Captured on a Topcon TRC-50DX fundus camera, CFP, posterior pole view, 2228 x 1652 pixels, mydriatic (tropicamide and phenylephrine), FOV: 50 degrees
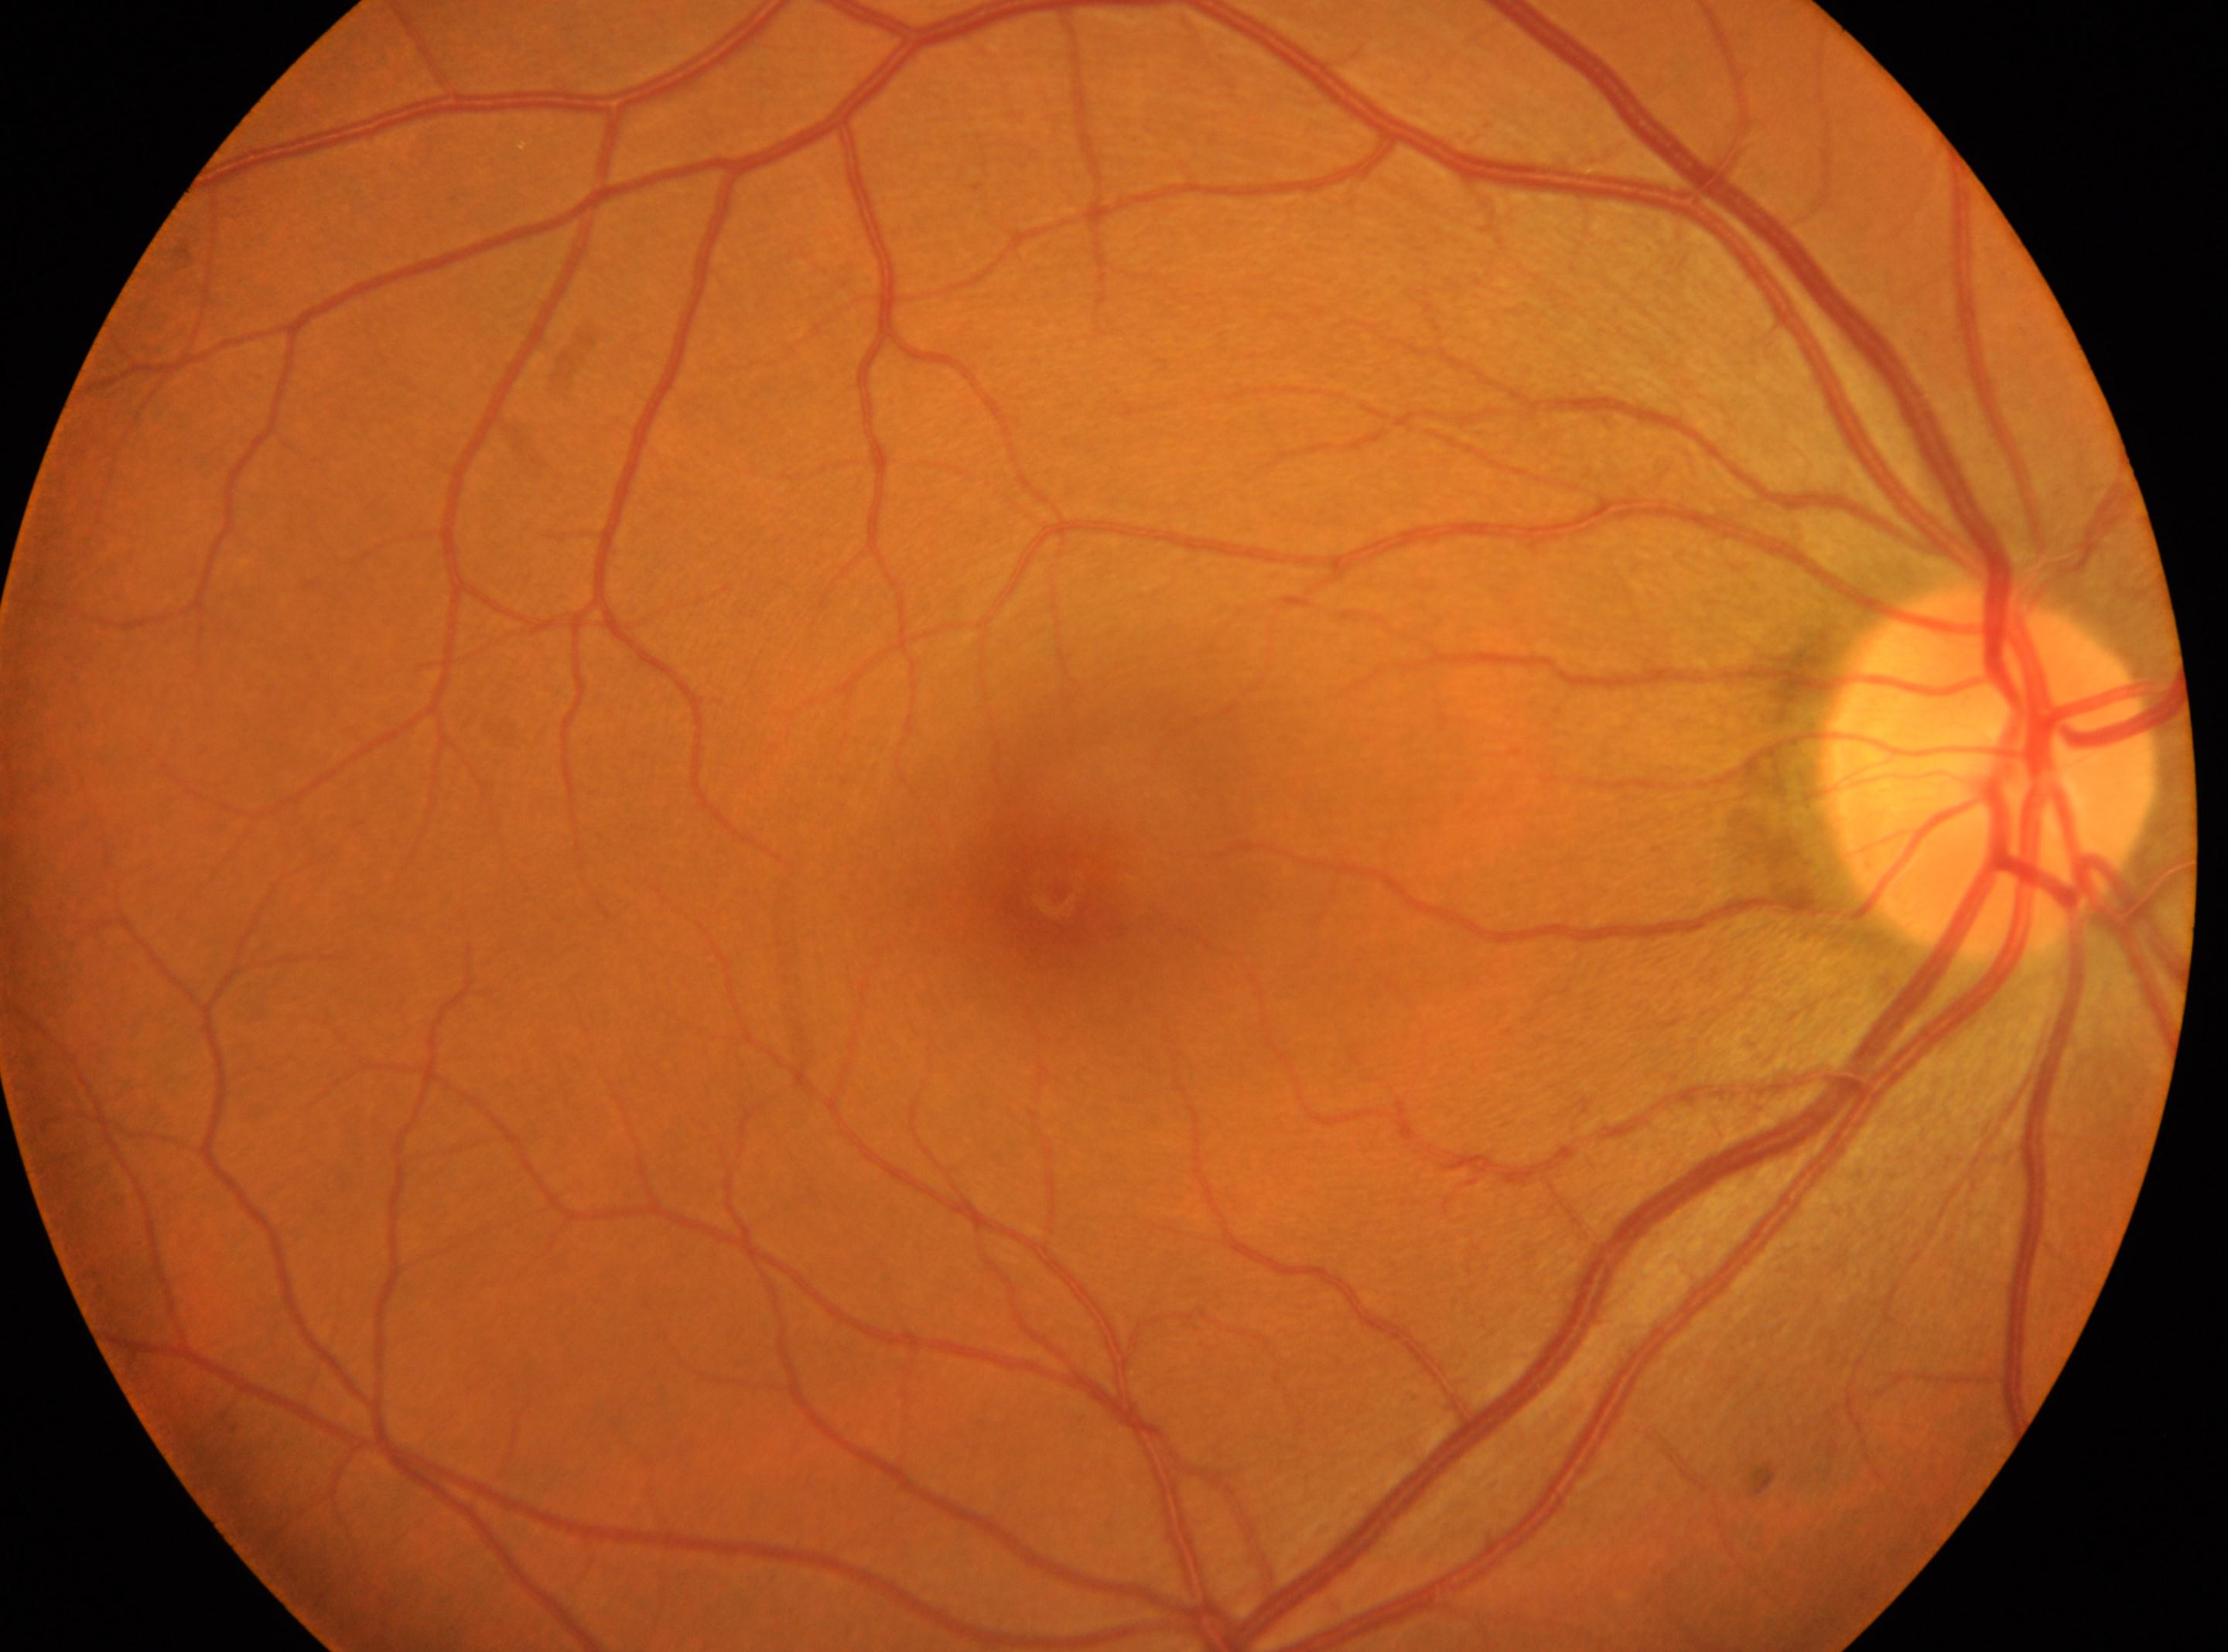
optic nerve head: 1991, 772 | OD | macular center: 1058, 894 | diabetic retinopathy (DR): grade 0.